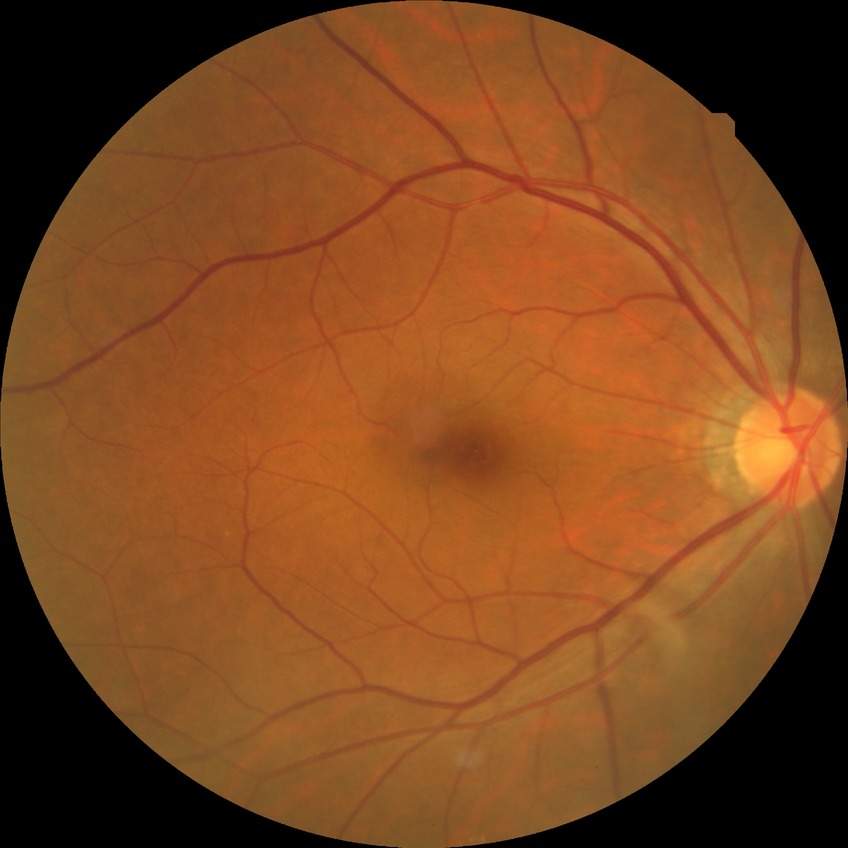
Diabetic retinopathy grade is no diabetic retinopathy.